Pediatric retinal photograph (wide-field):
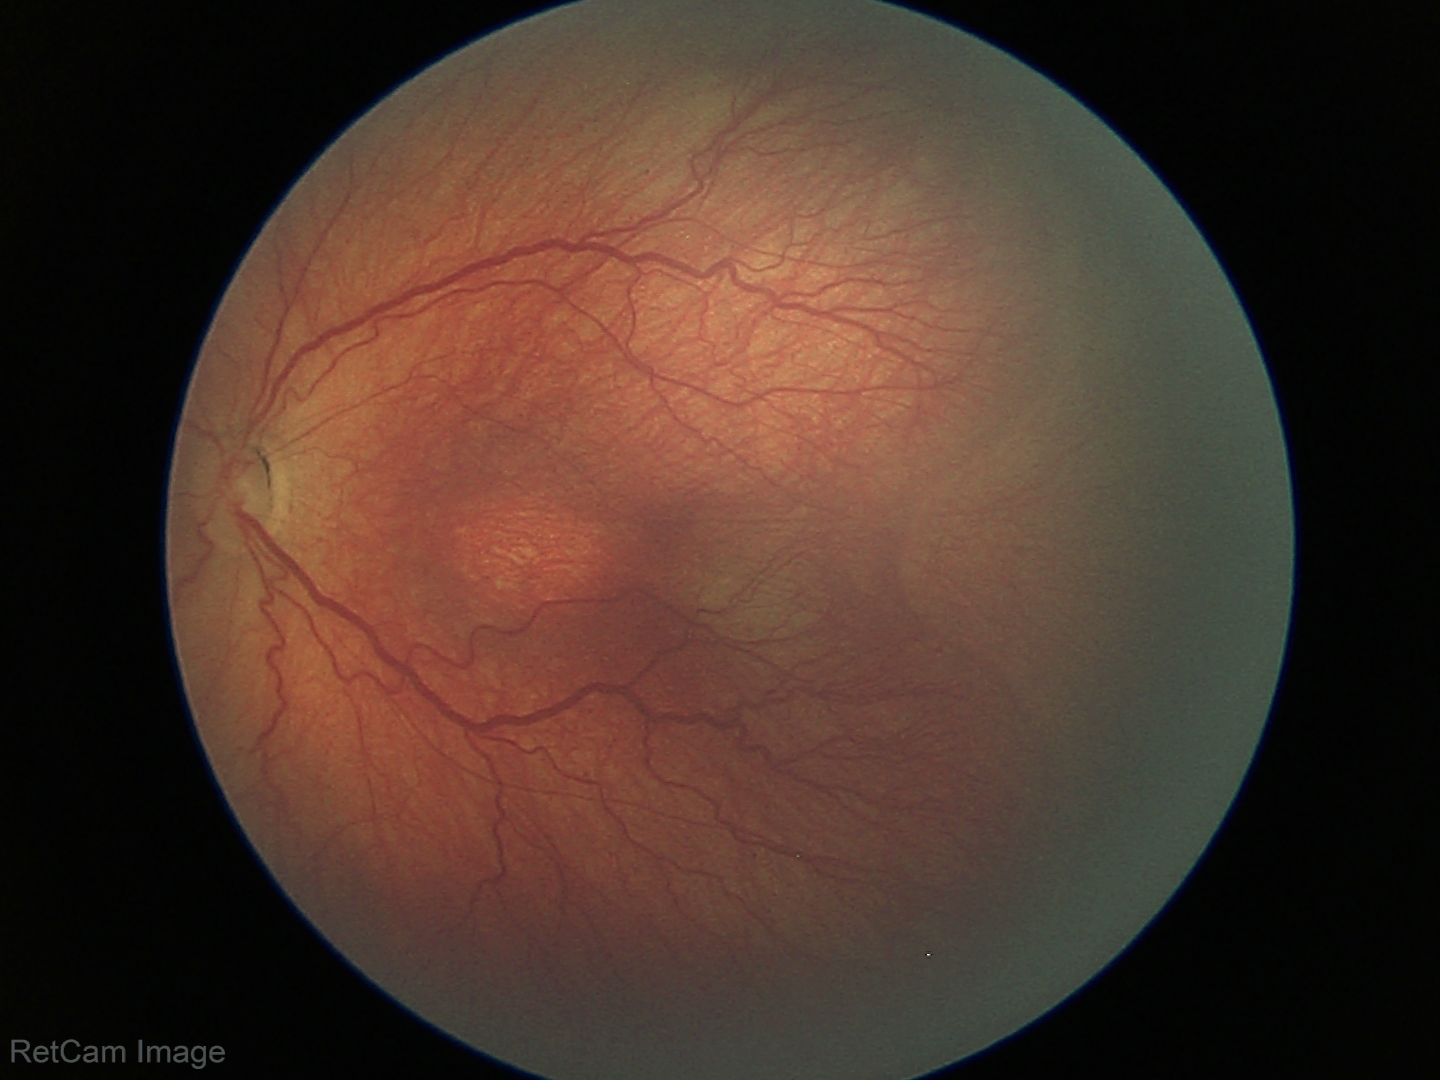

Finding: retinopathy of prematurity (ROP) stage 3 | plus form: absent.